Retinal fundus photograph: 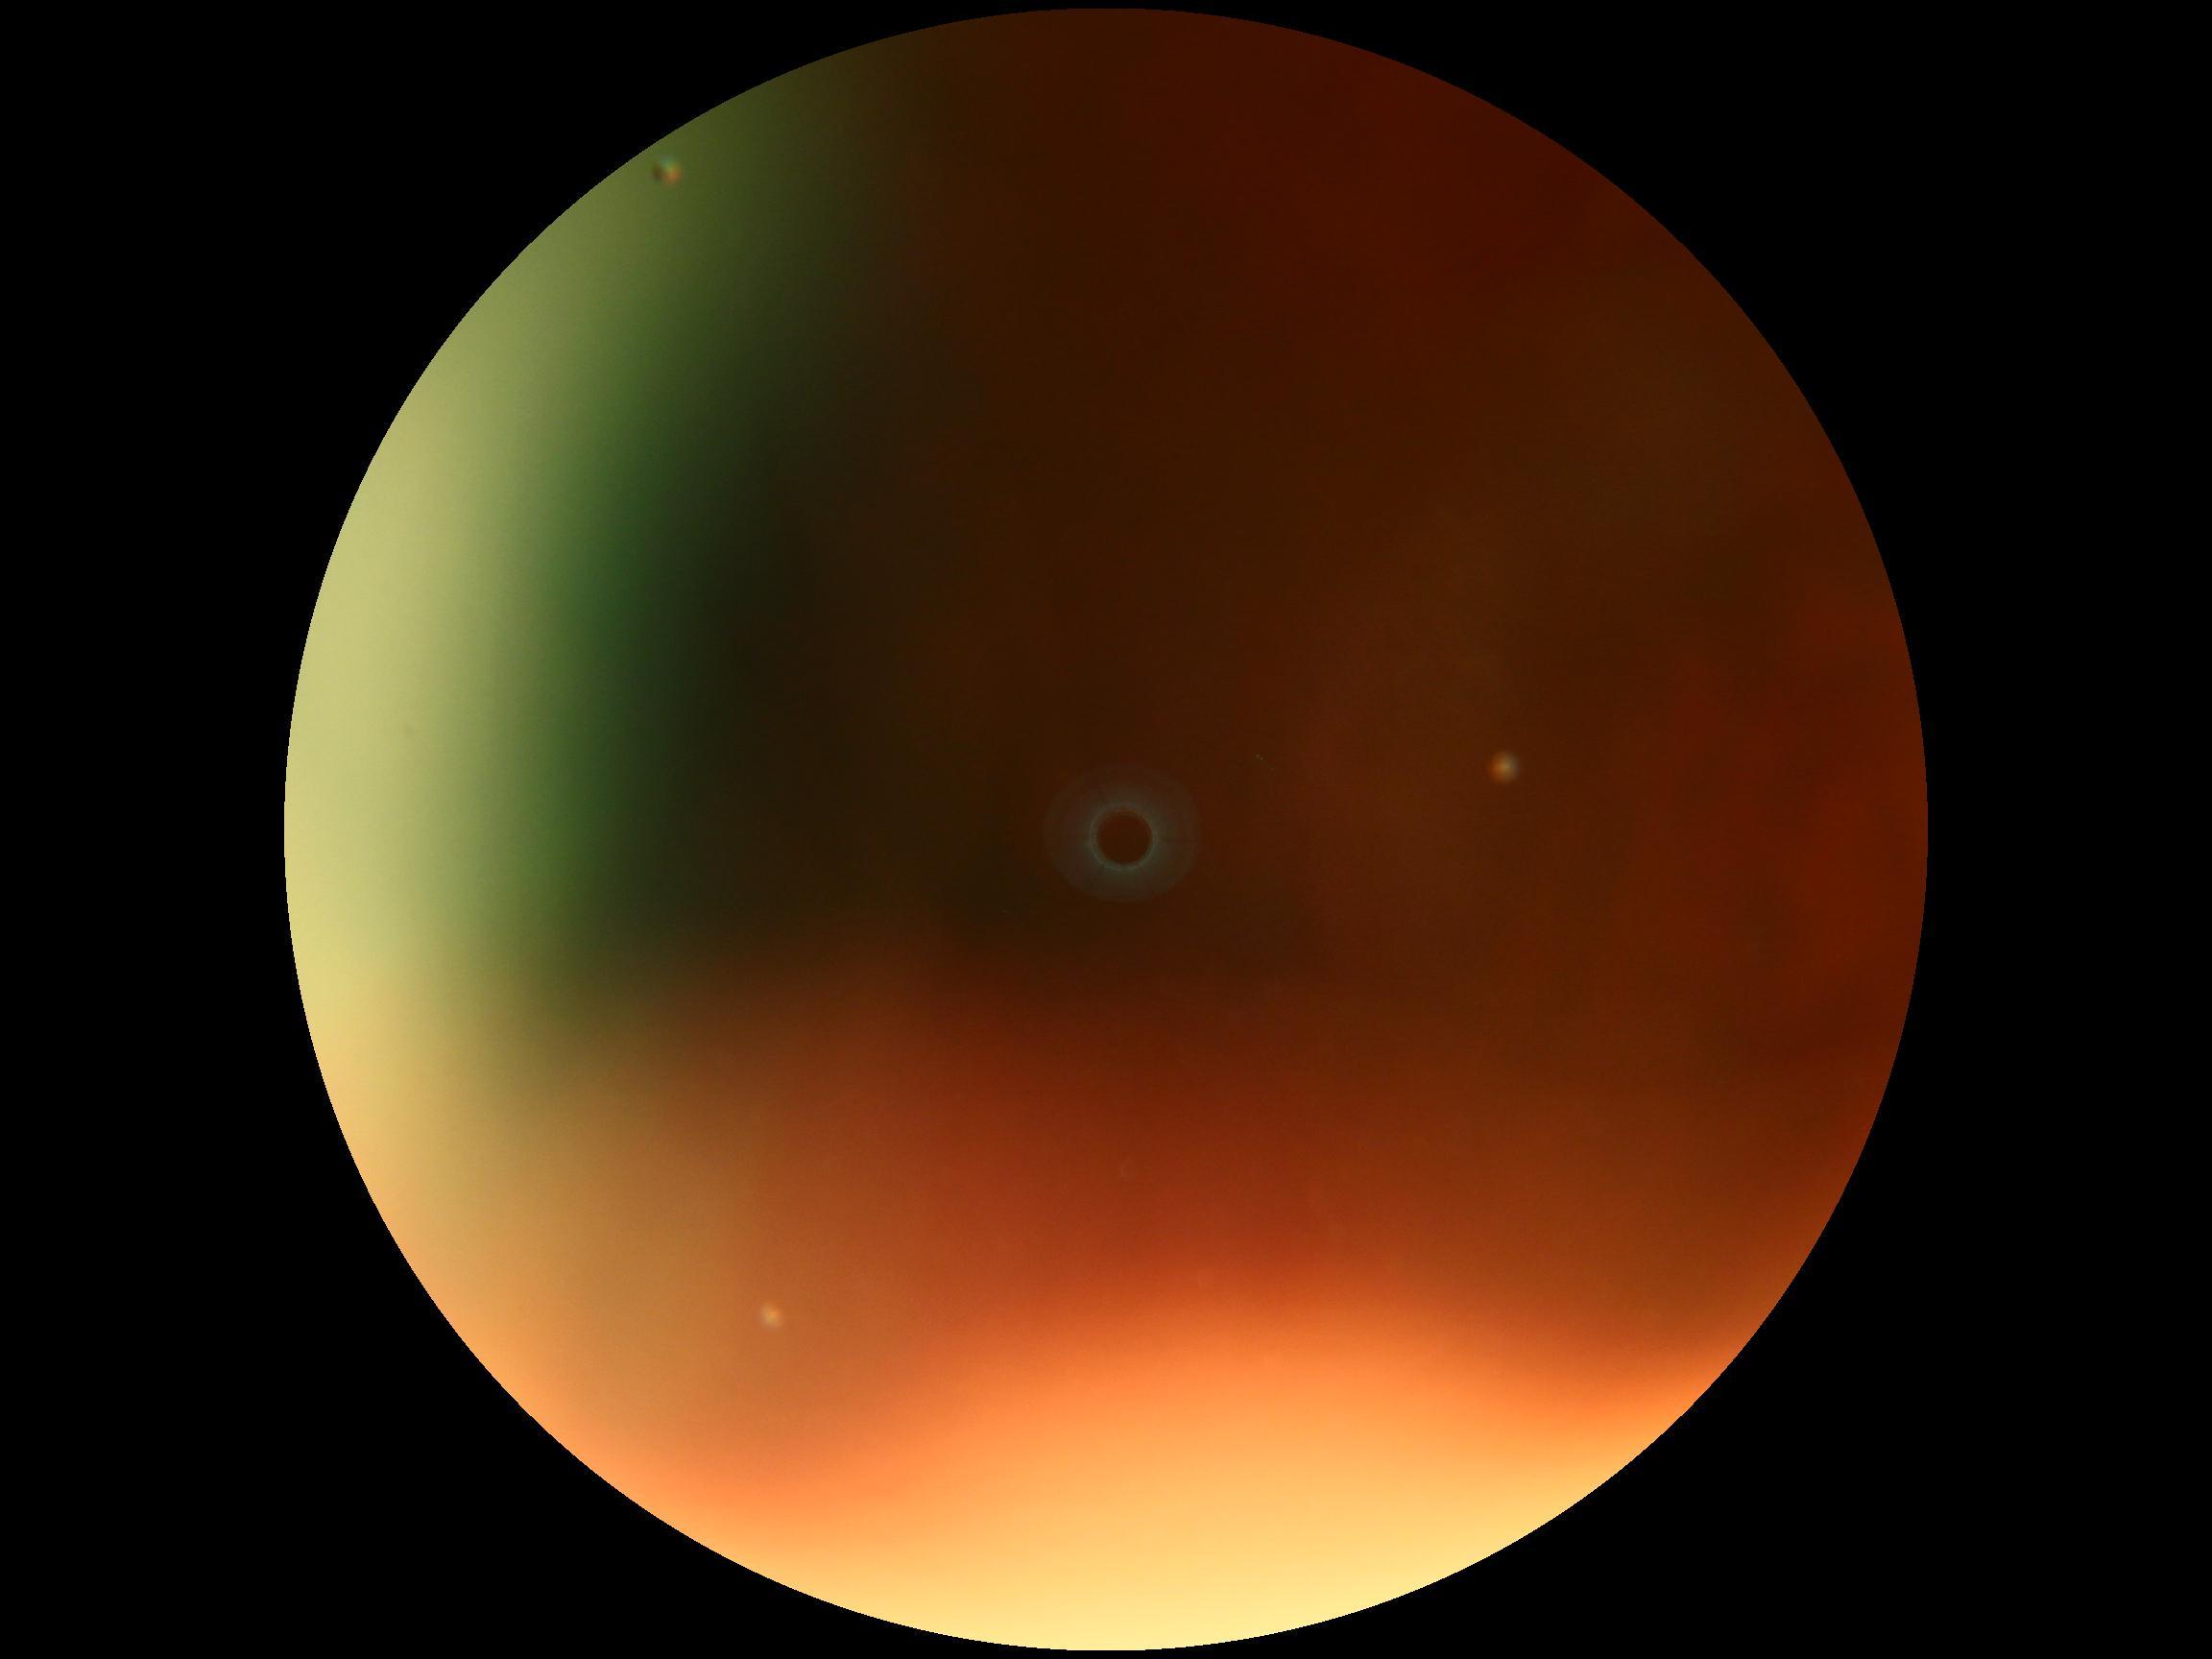

diabetic retinopathy: ungradable; image quality: insufficient.